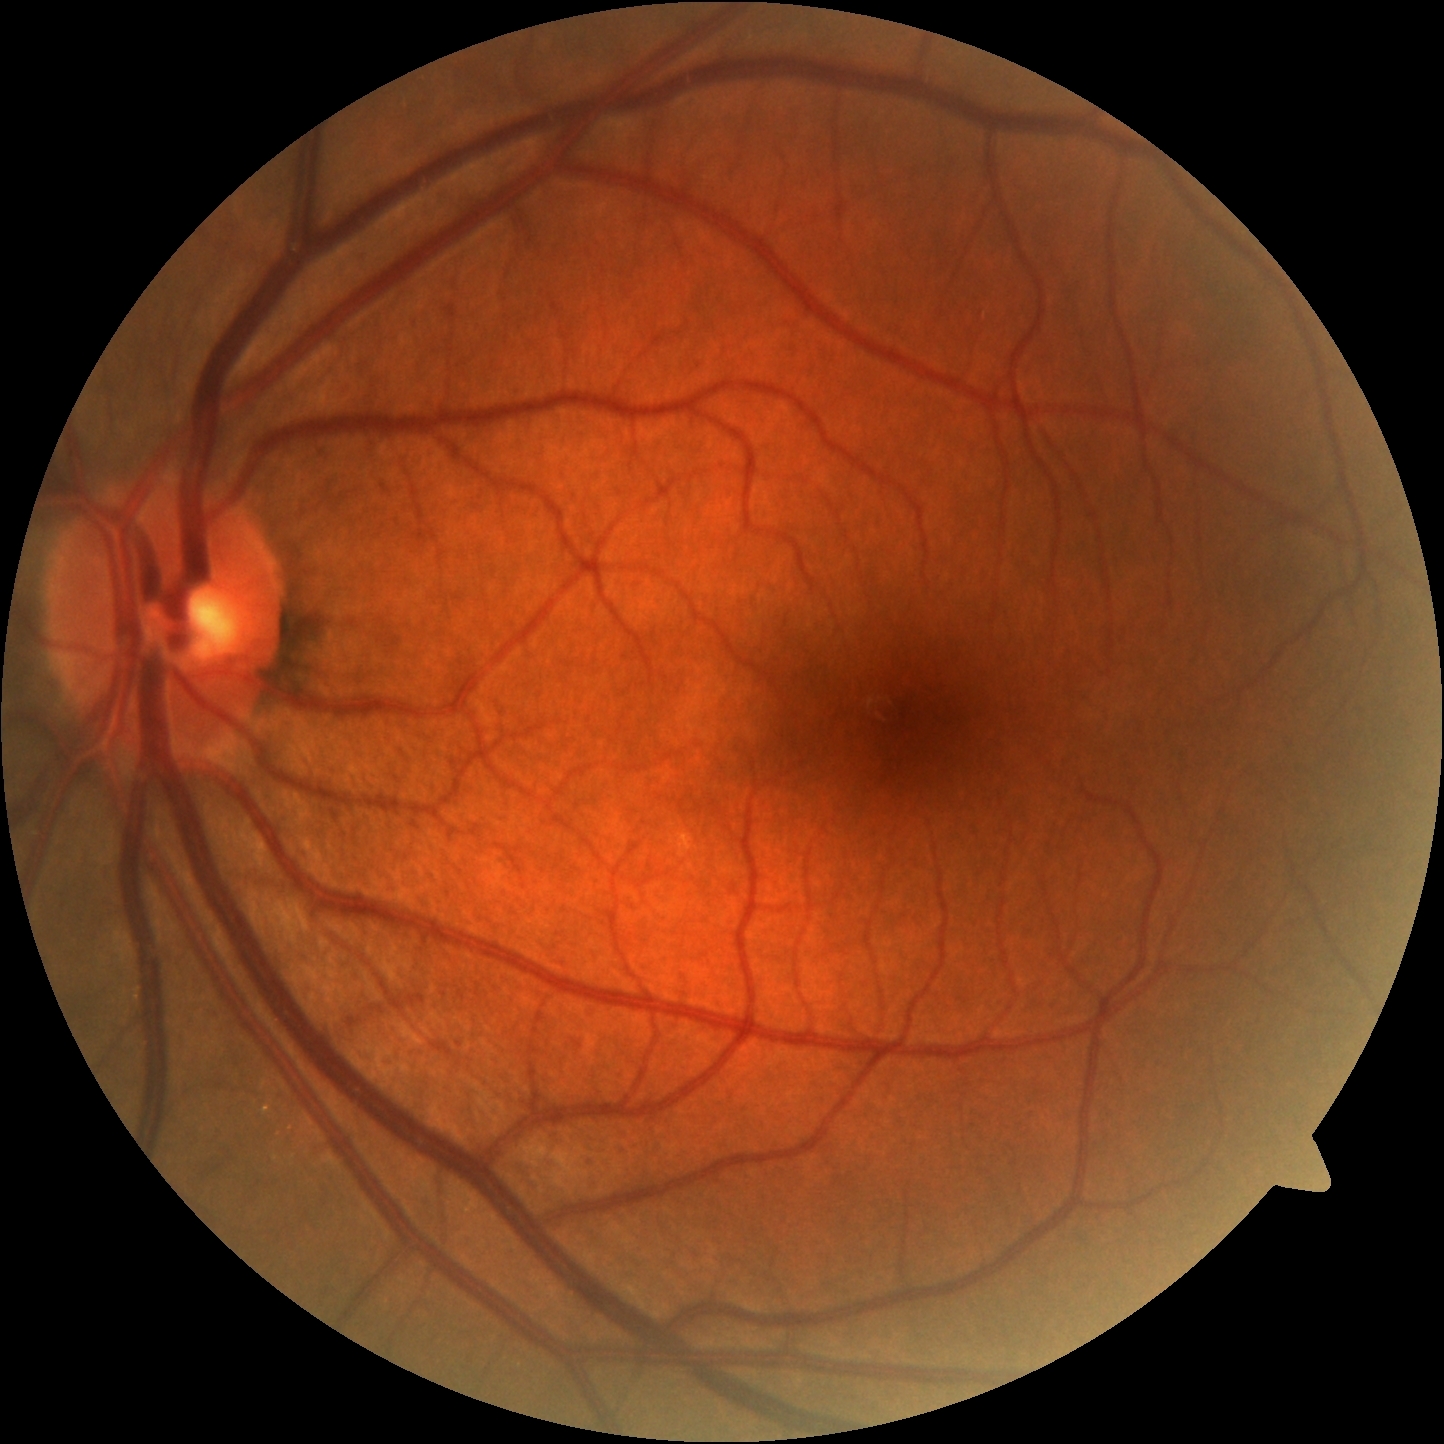
dr_grade: grade 0 (no apparent retinopathy)